1534x1534. FOV: 50 degrees. Color fundus photograph.
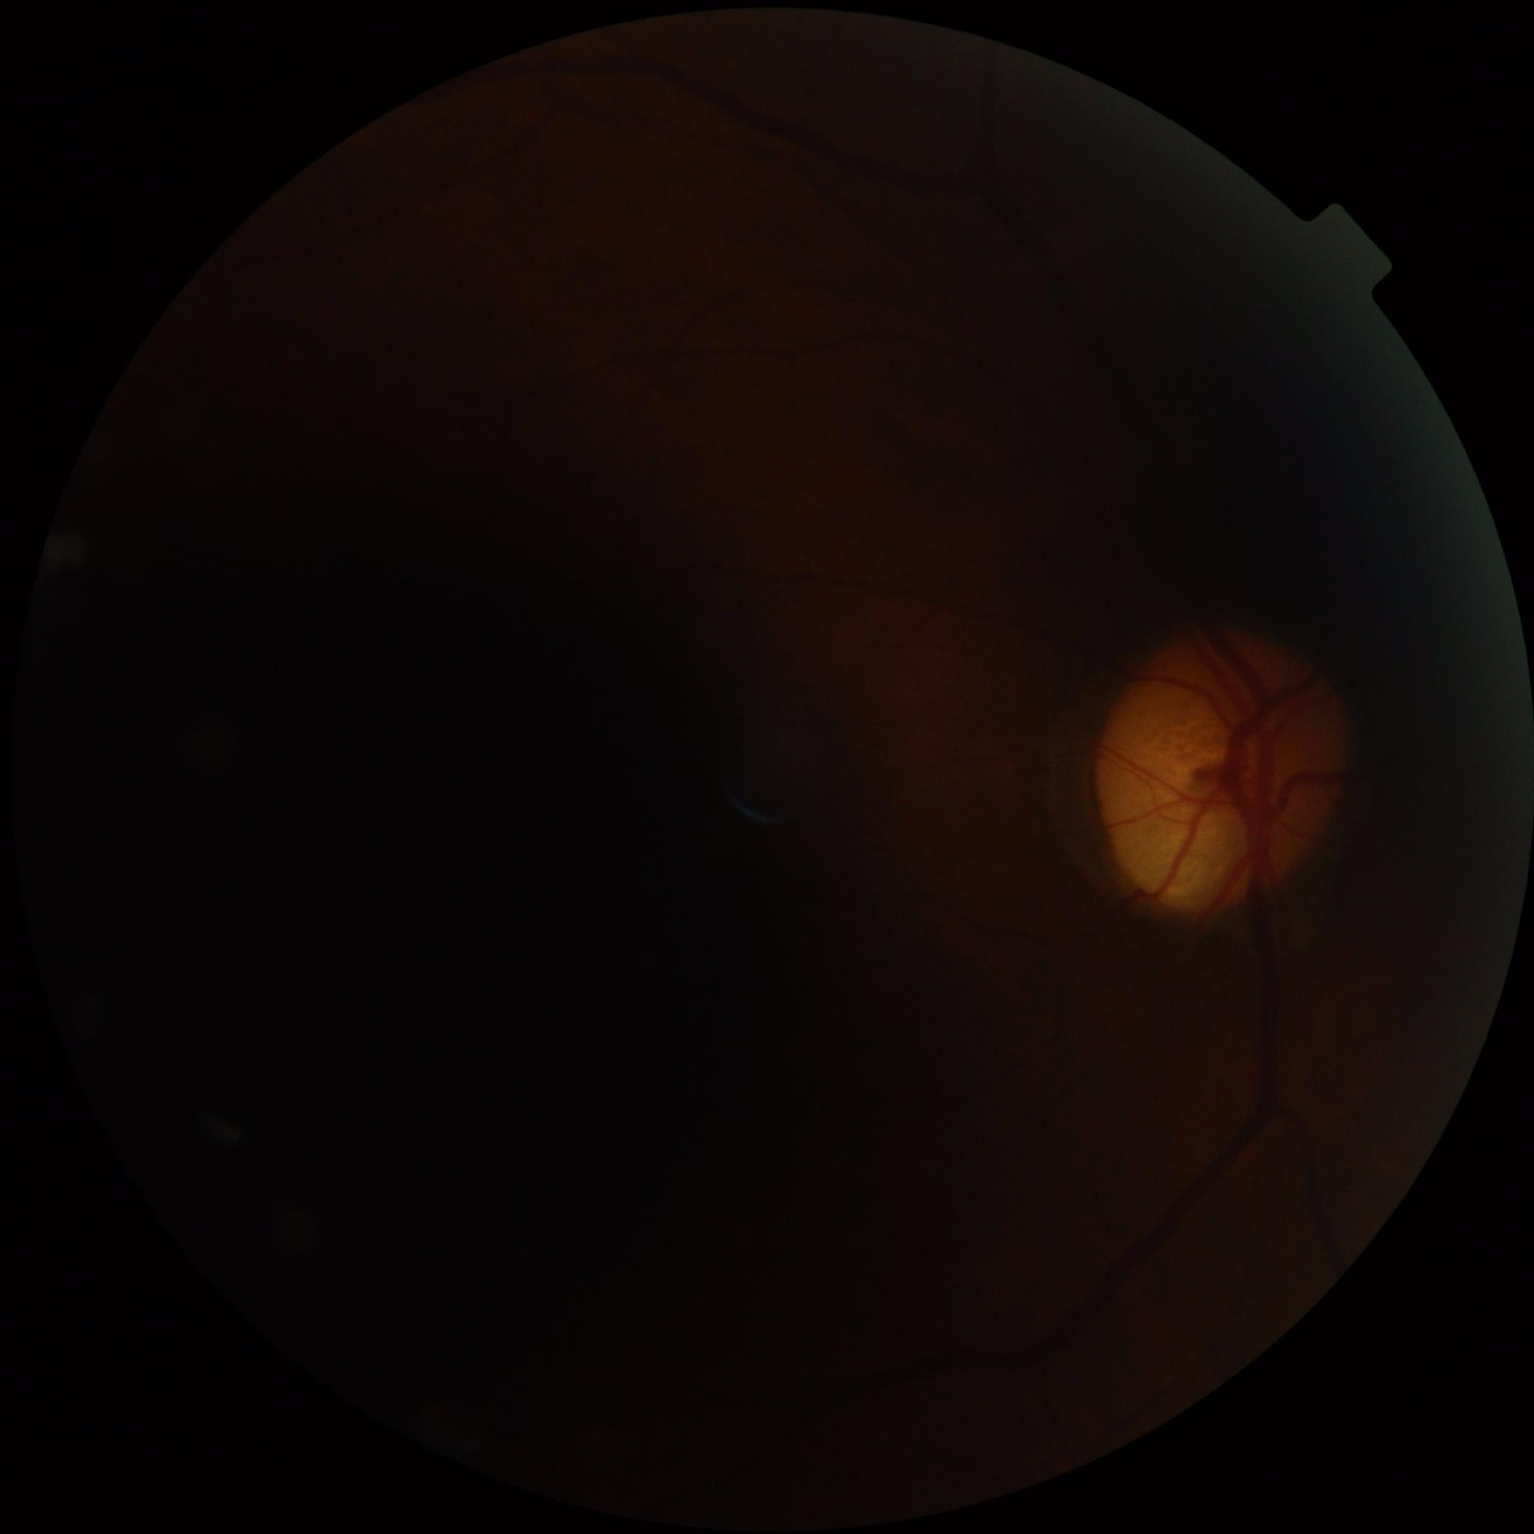

contrast: reduced
overall_quality: low
clarity: blurry
illumination: uneven